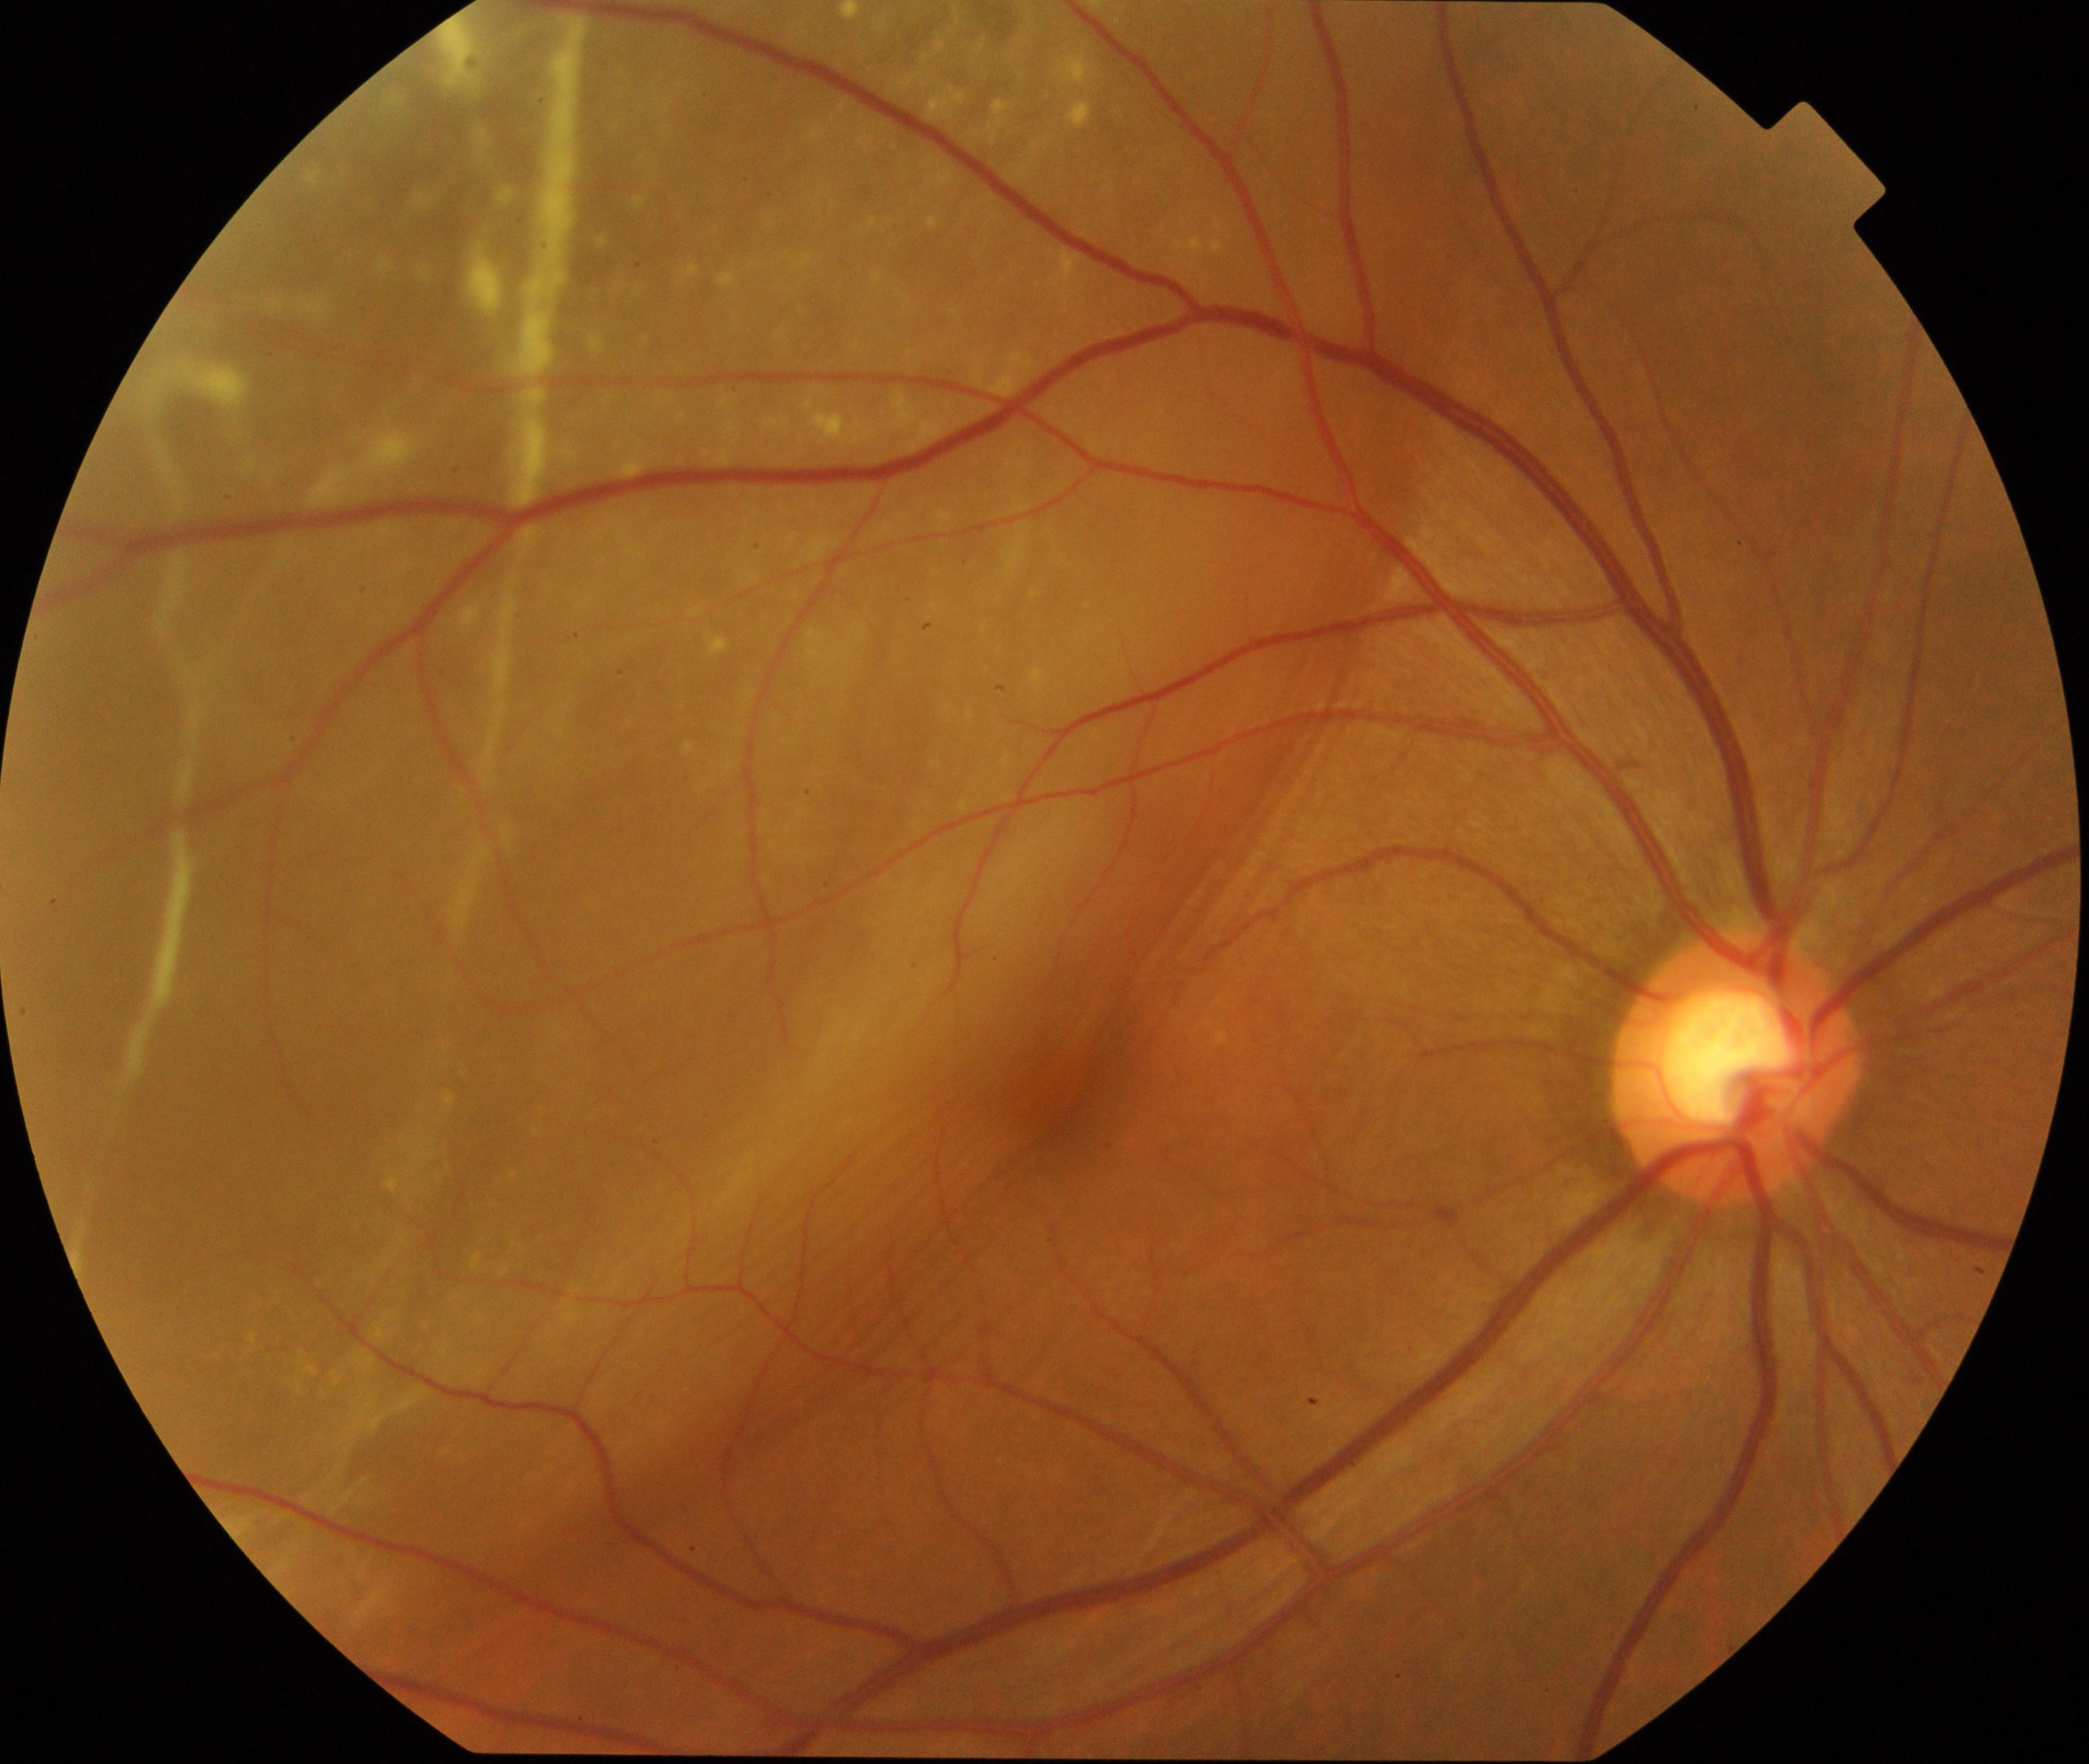

Findings: rhegmatogenous retinal detachment.